FOV: 45 degrees; image size 1960x1897; CFP: 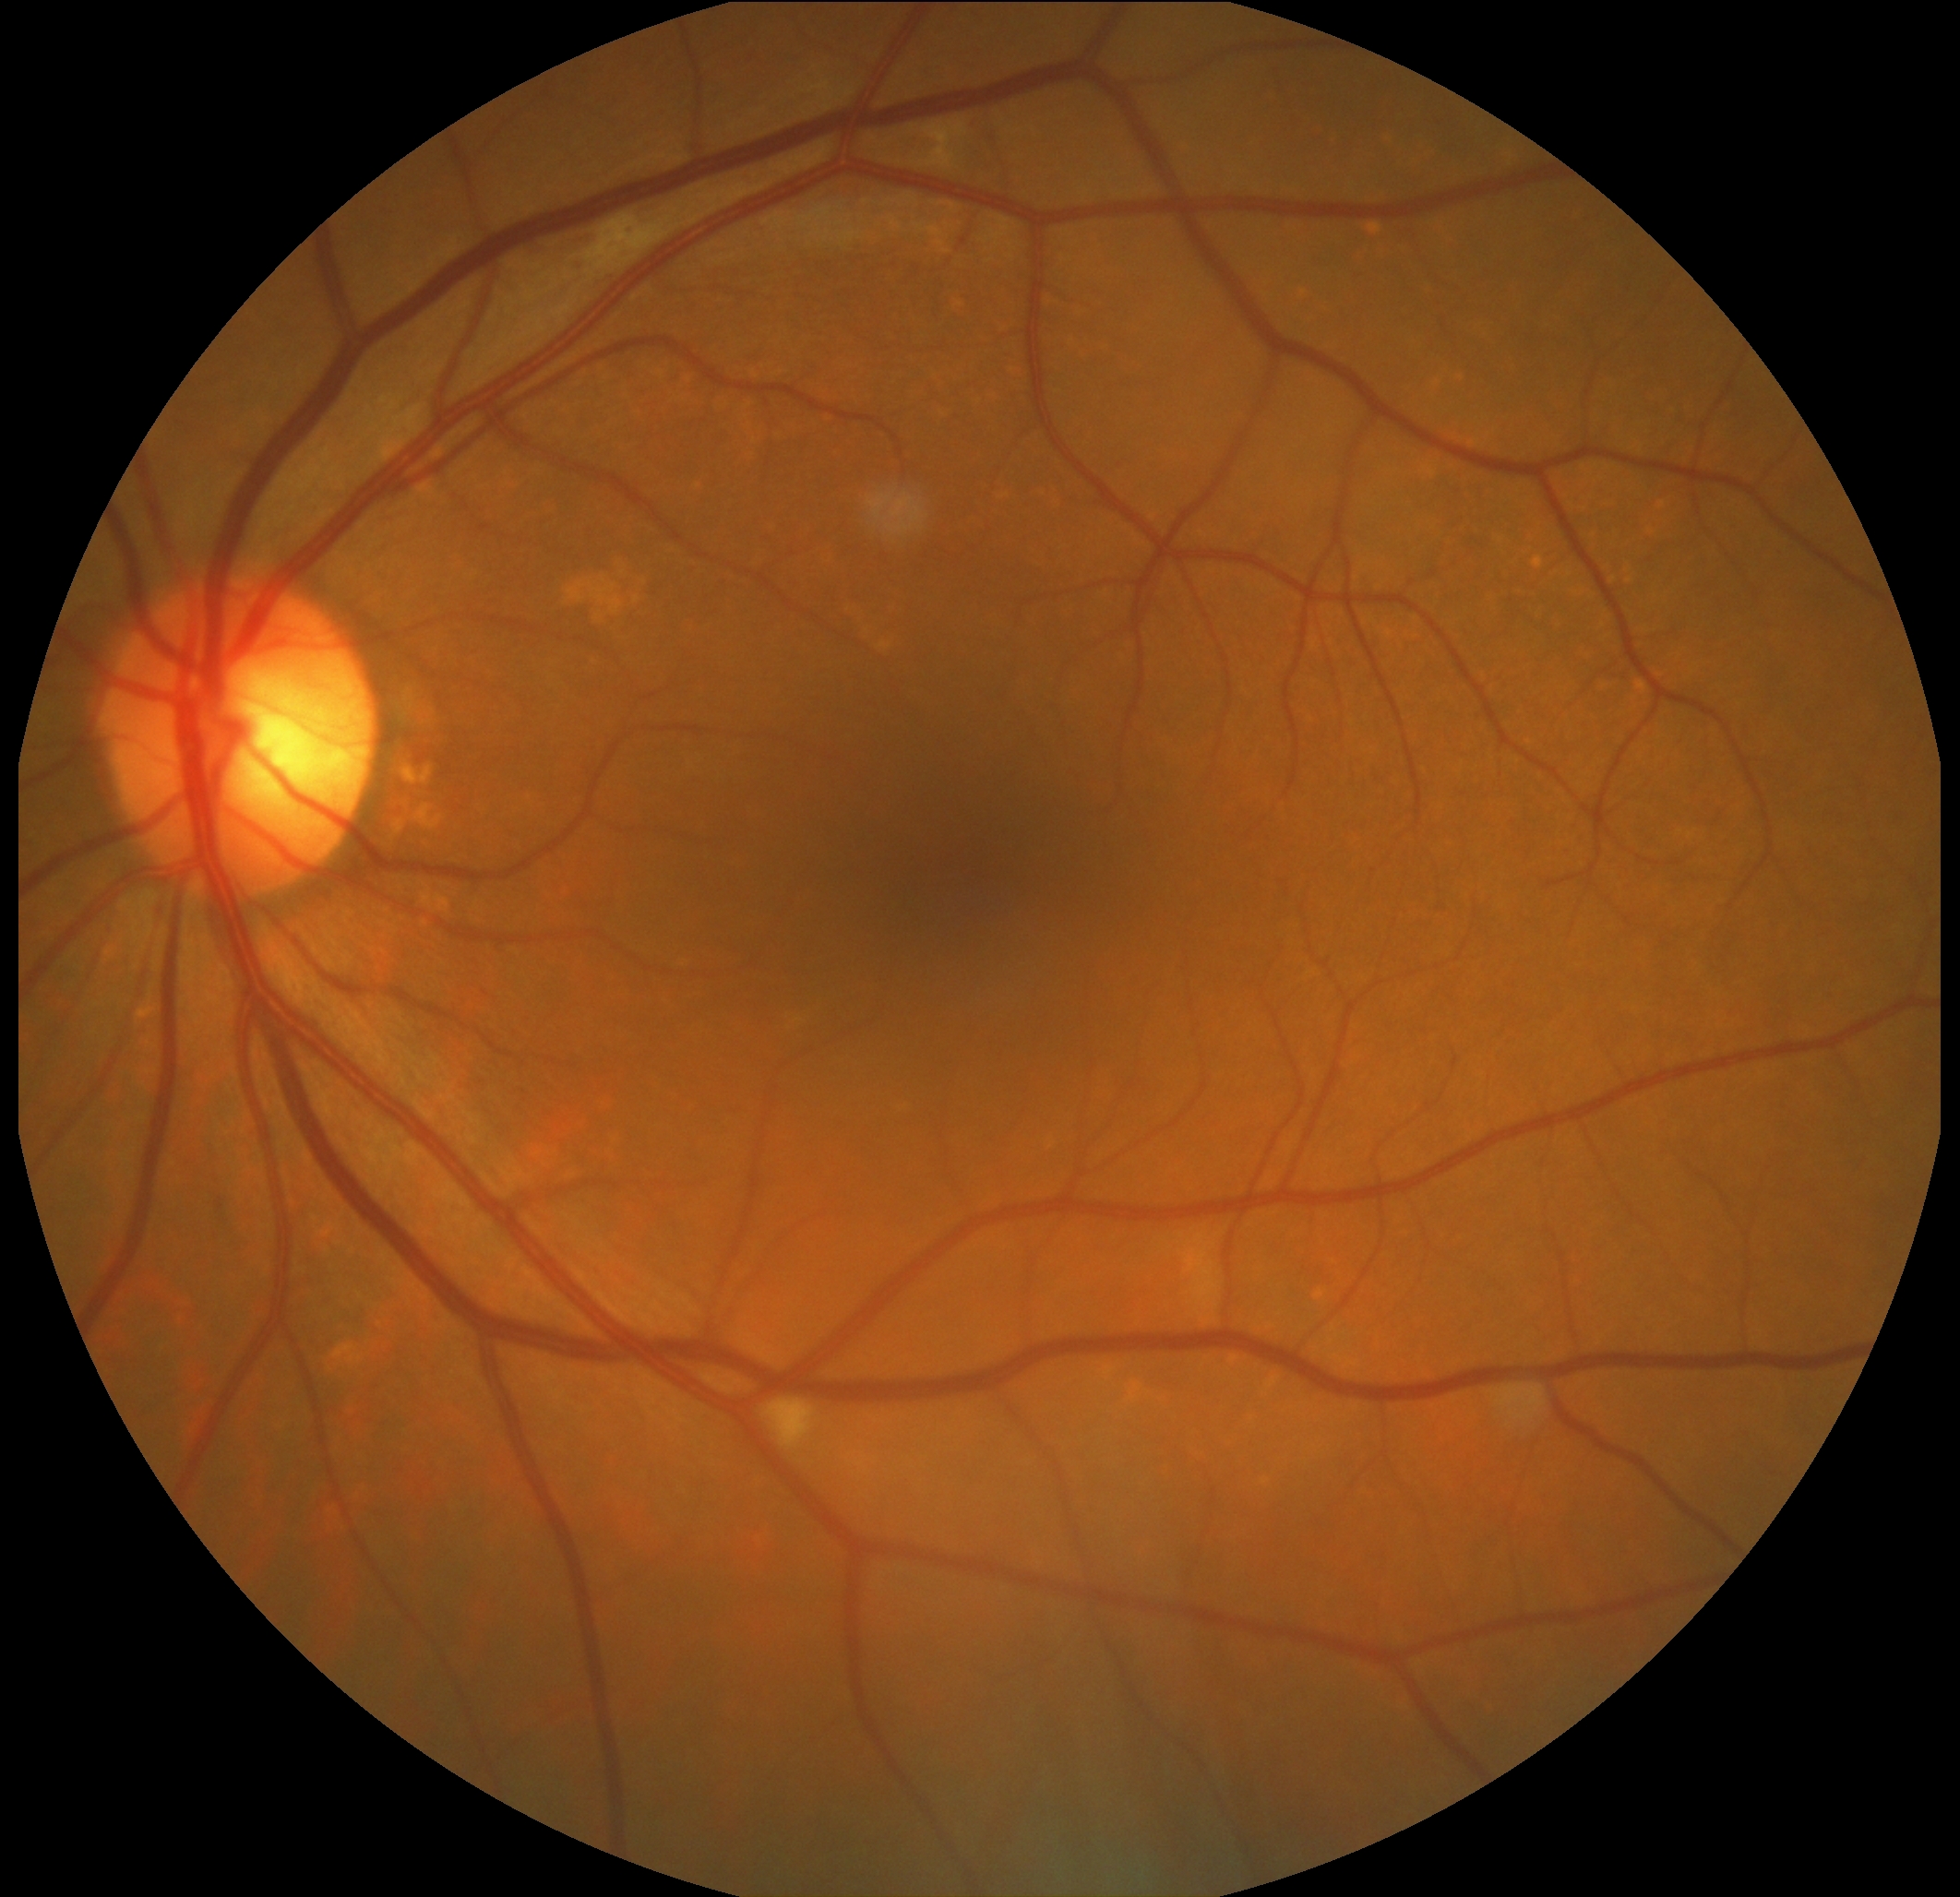
DR severity is 2/4.